Wide-field fundus photograph from neonatal ROP screening. Camera: Phoenix ICON (100° FOV).
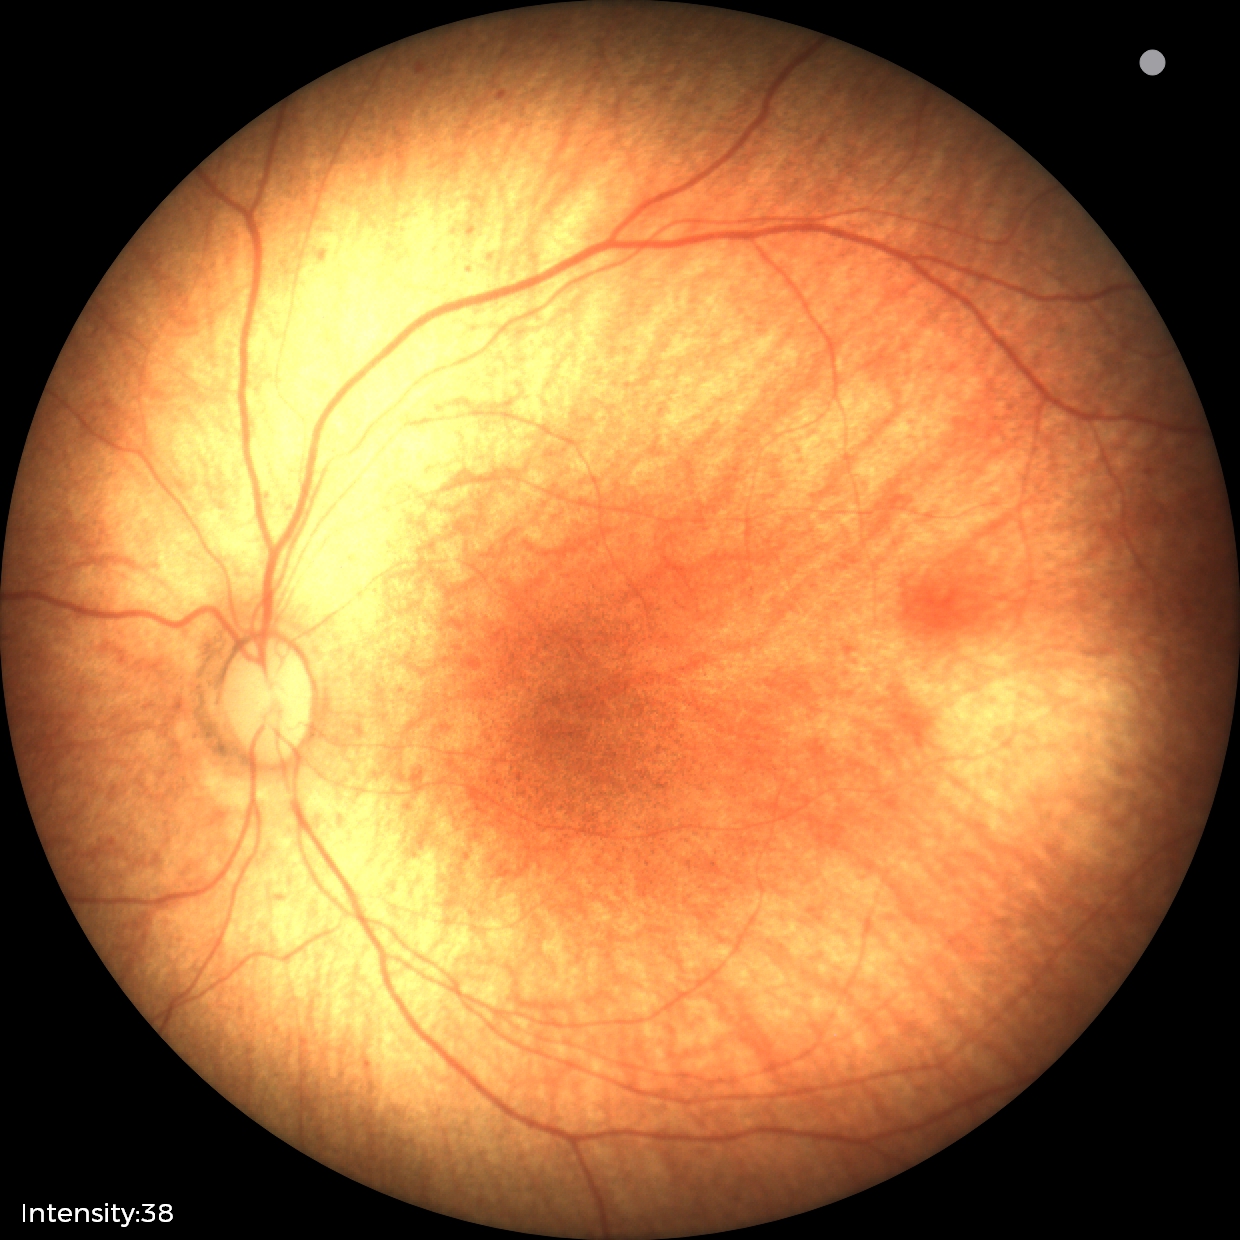
Screening examination diagnosed as physiological.